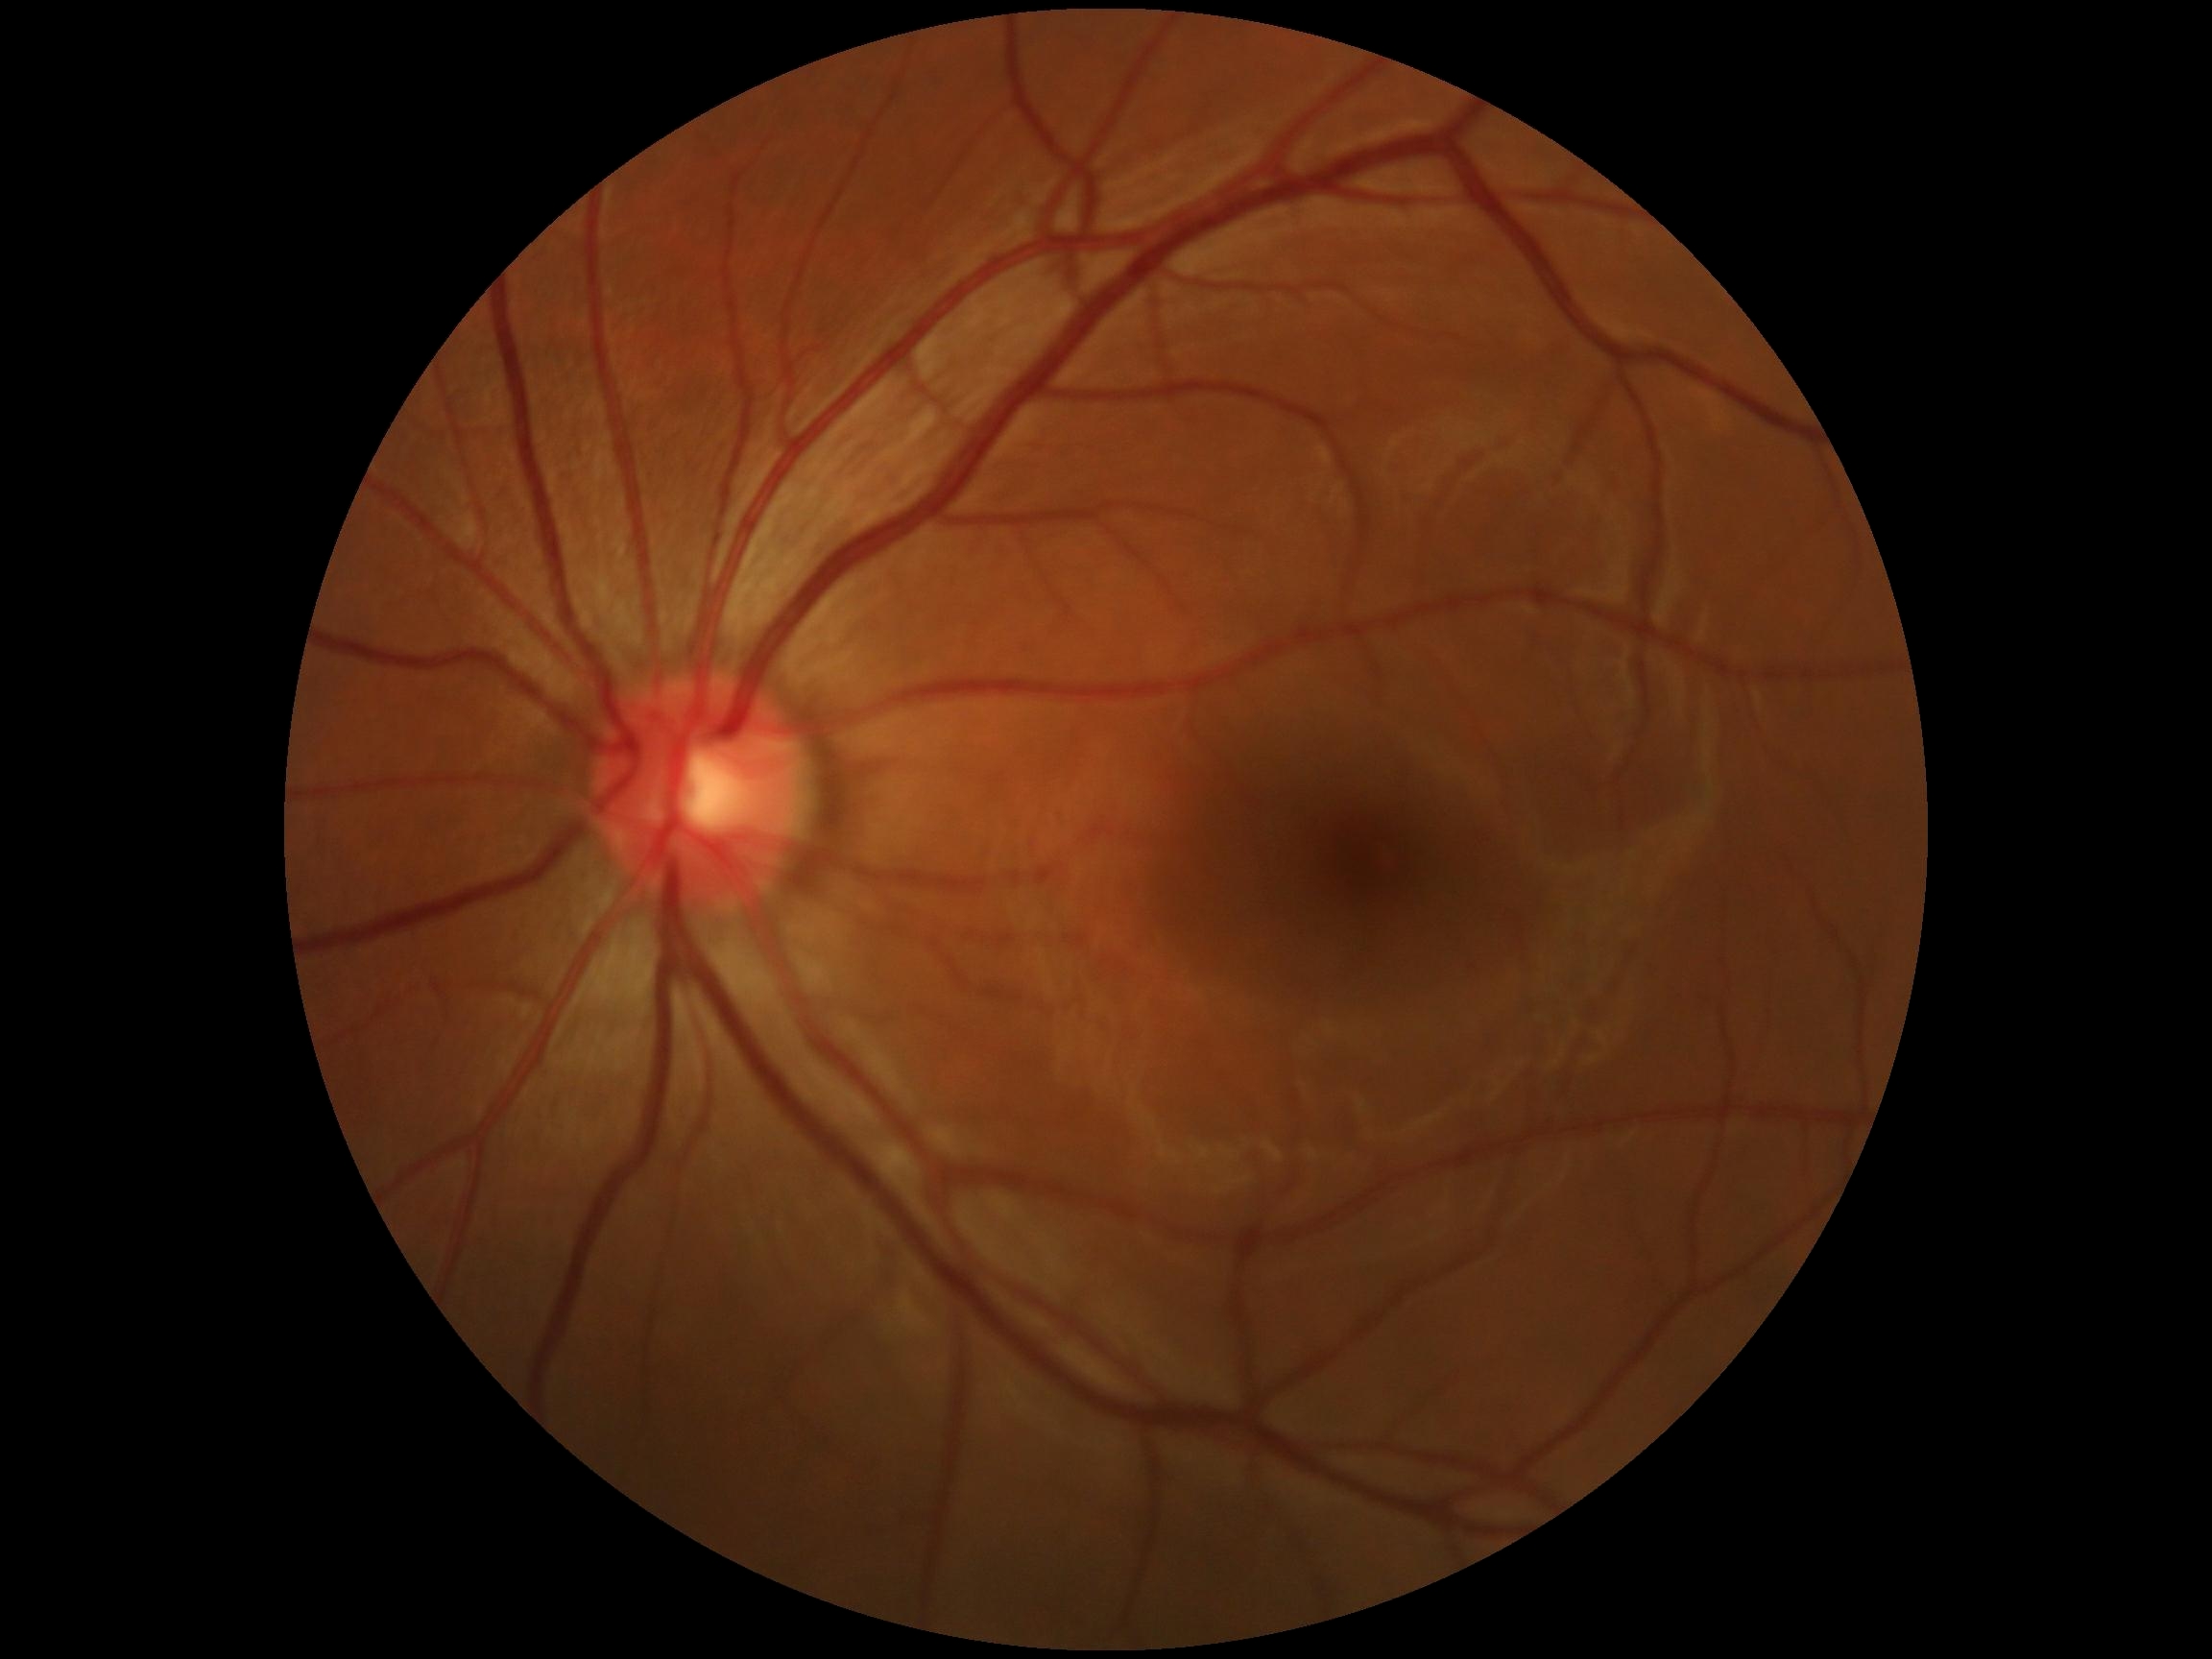

DR stage is no apparent retinopathy (grade 0).